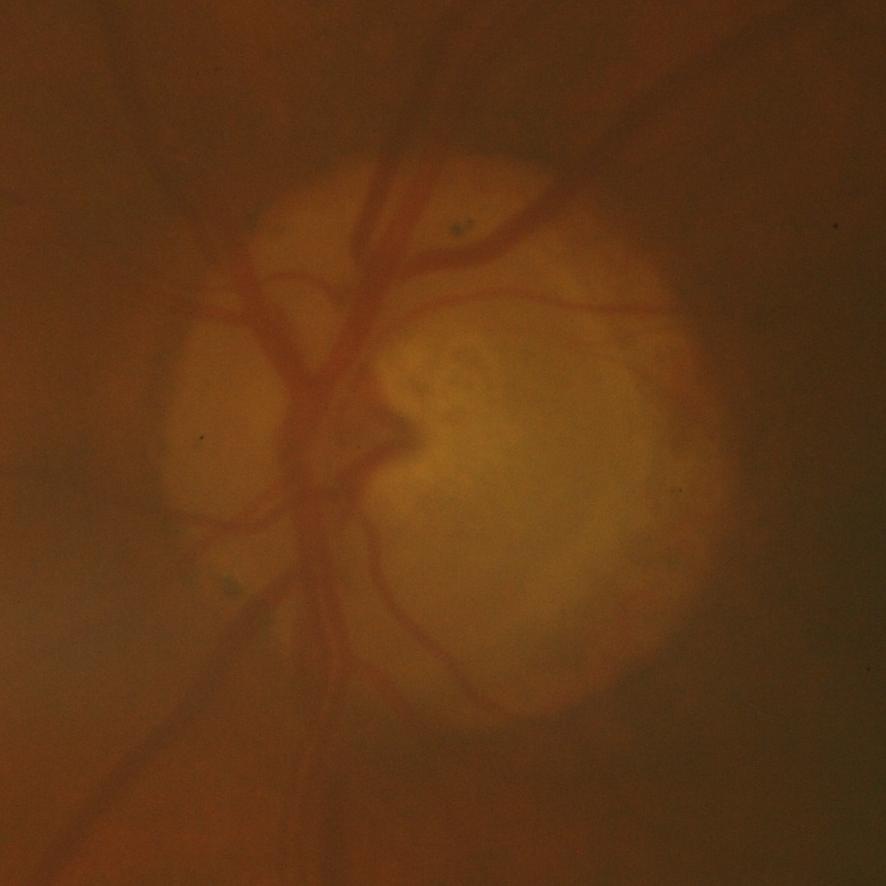

Glaucoma status: glaucomatous findings.